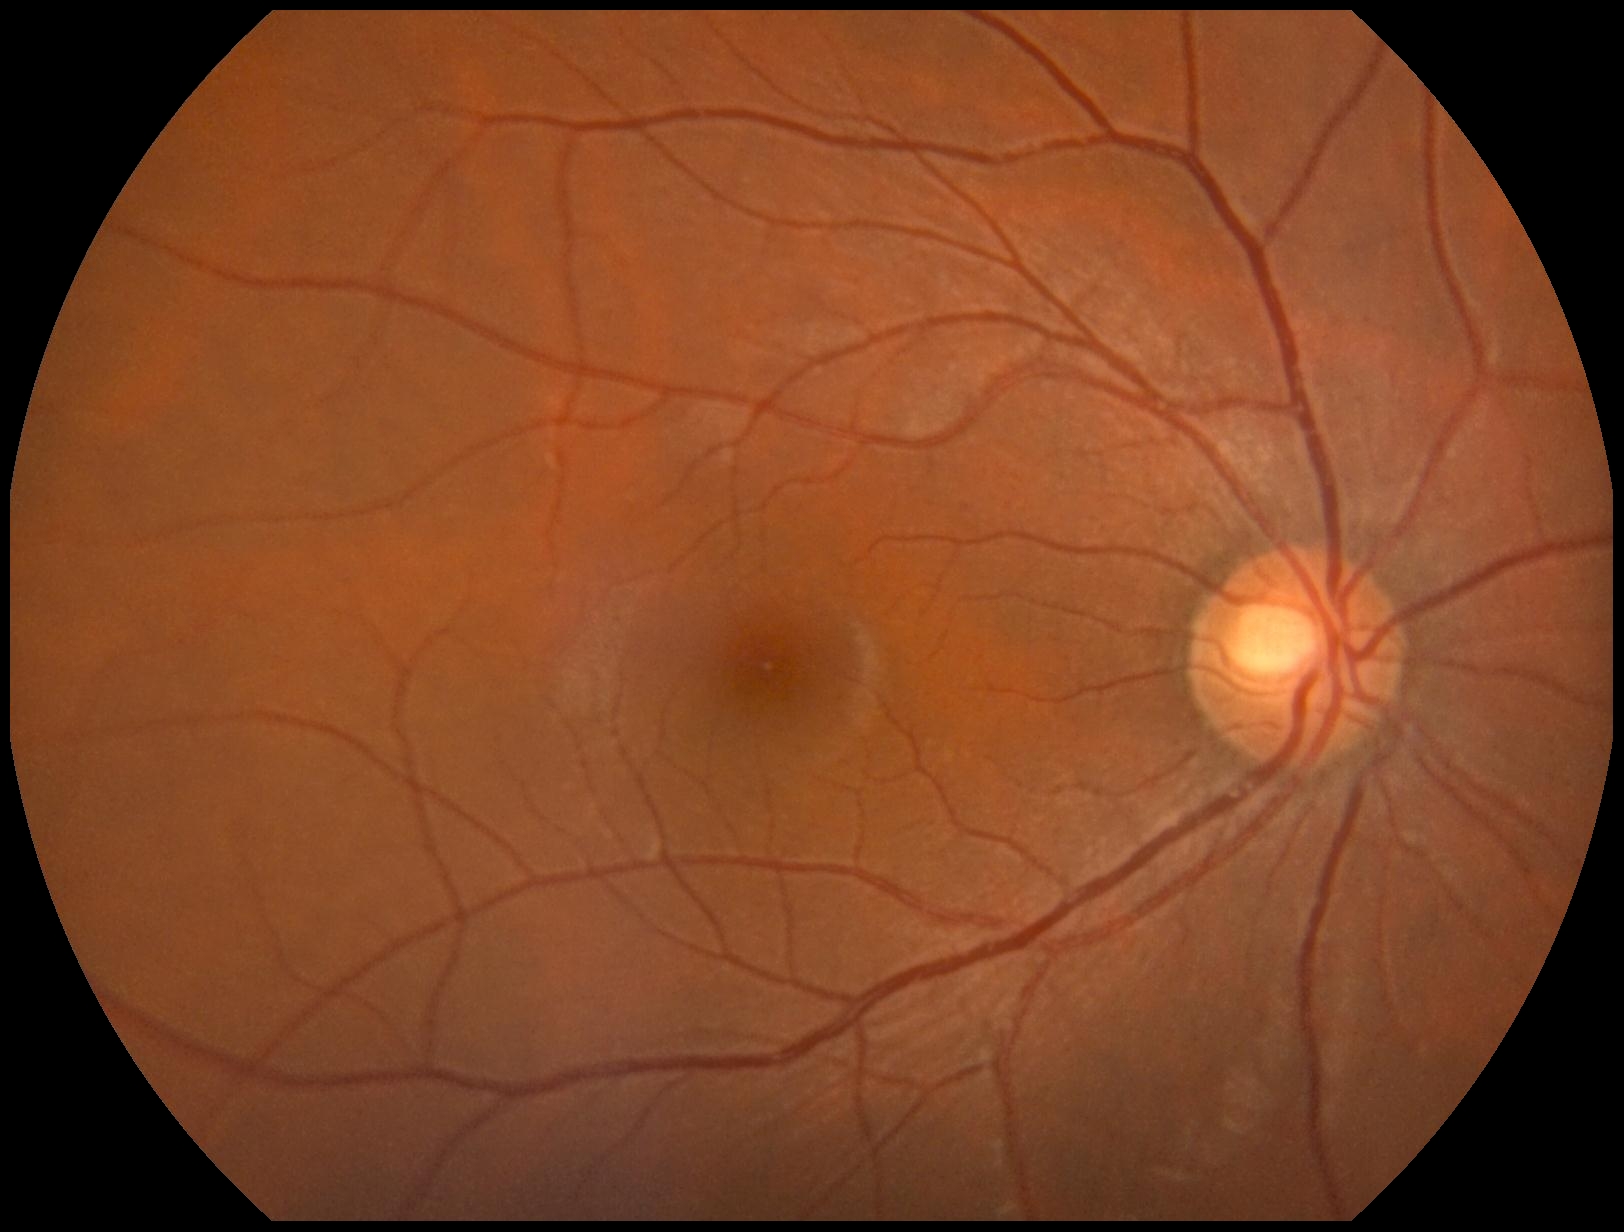

DR grade is 0 (no apparent retinopathy).